Tabletop color fundus camera image — 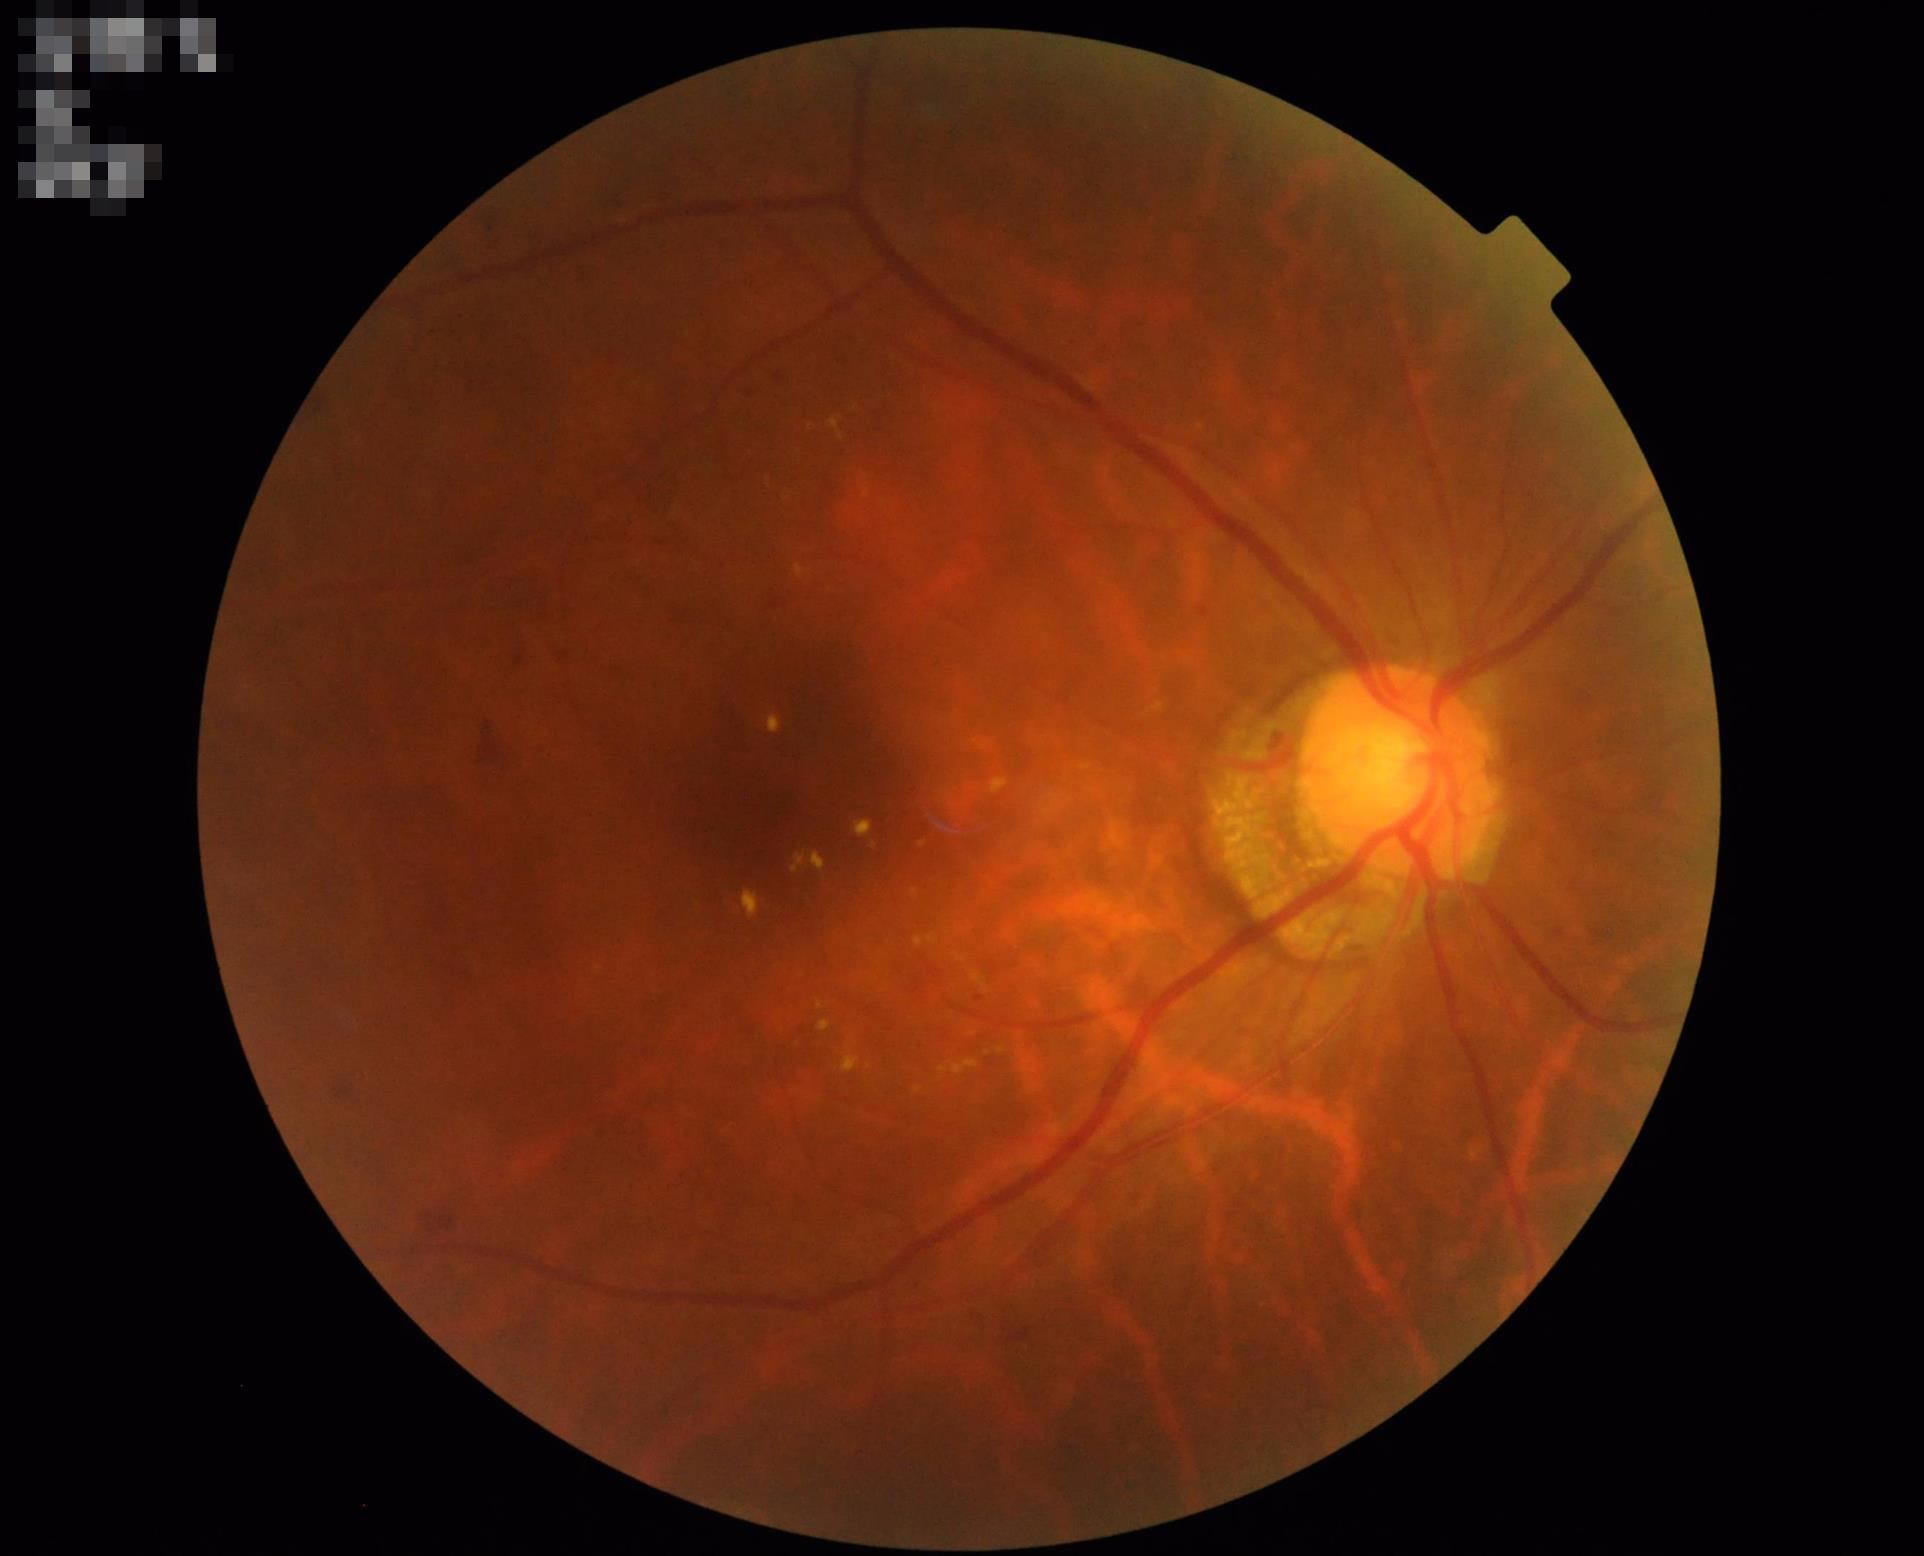
Optic disc, vessels, and background are in focus.
Adequate contrast for distinguishing structures.
Illumination and color balance are good.
Overall quality is good and the image is gradable.